Modified Davis grading:
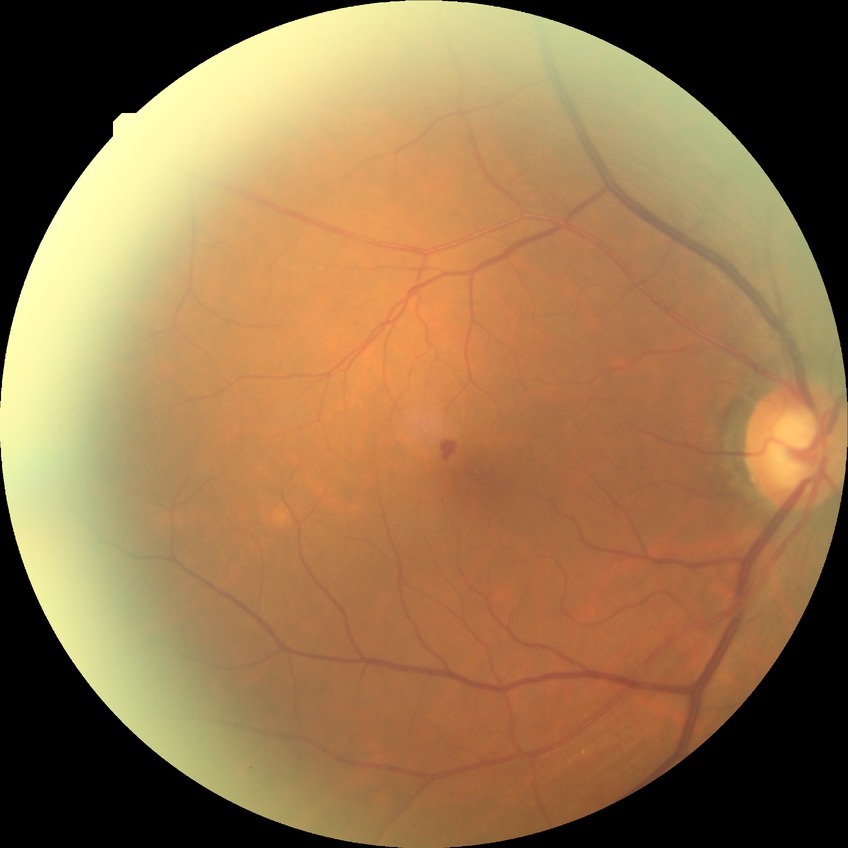

Diabetic retinopathy severity: simple diabetic retinopathy.
DR class: non-proliferative diabetic retinopathy.